Captured without pupil dilation, 240x240px — 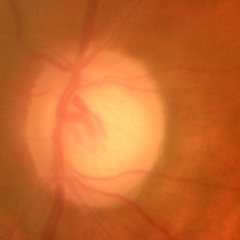 Glaucoma stage: early glaucoma.